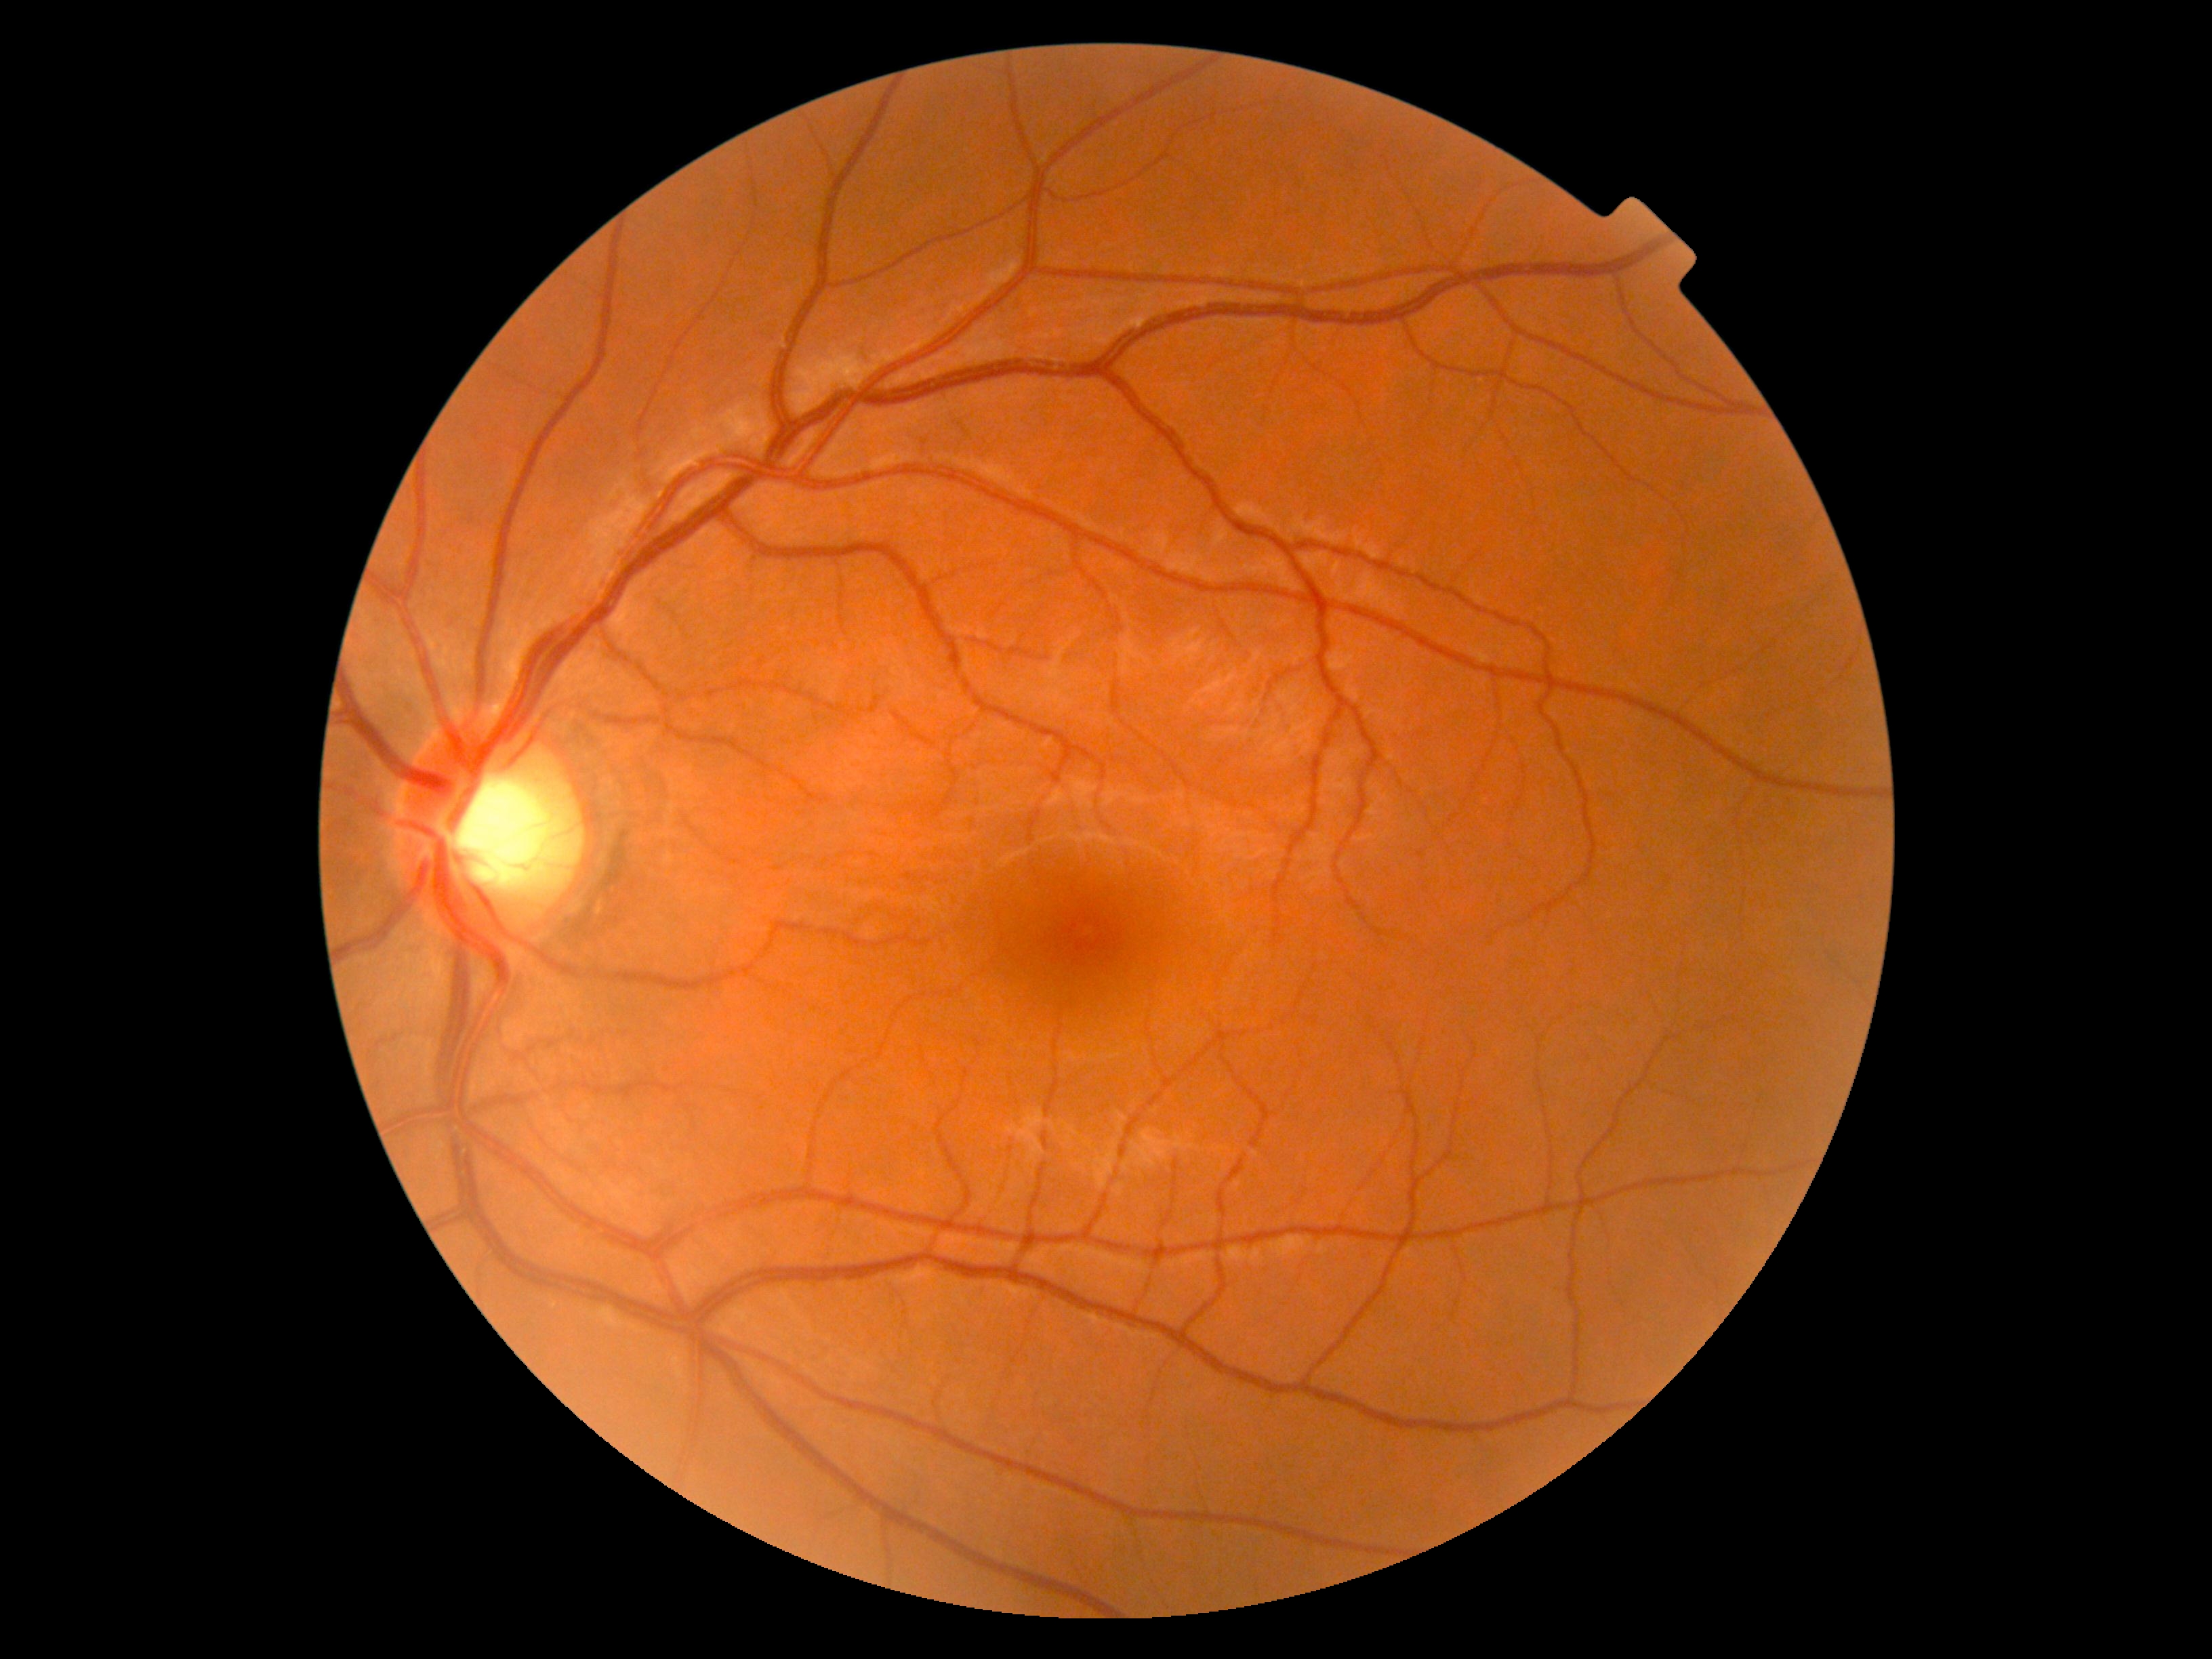

Diabetic retinopathy (DR): grade 0 (no apparent retinopathy).